45° field of view: 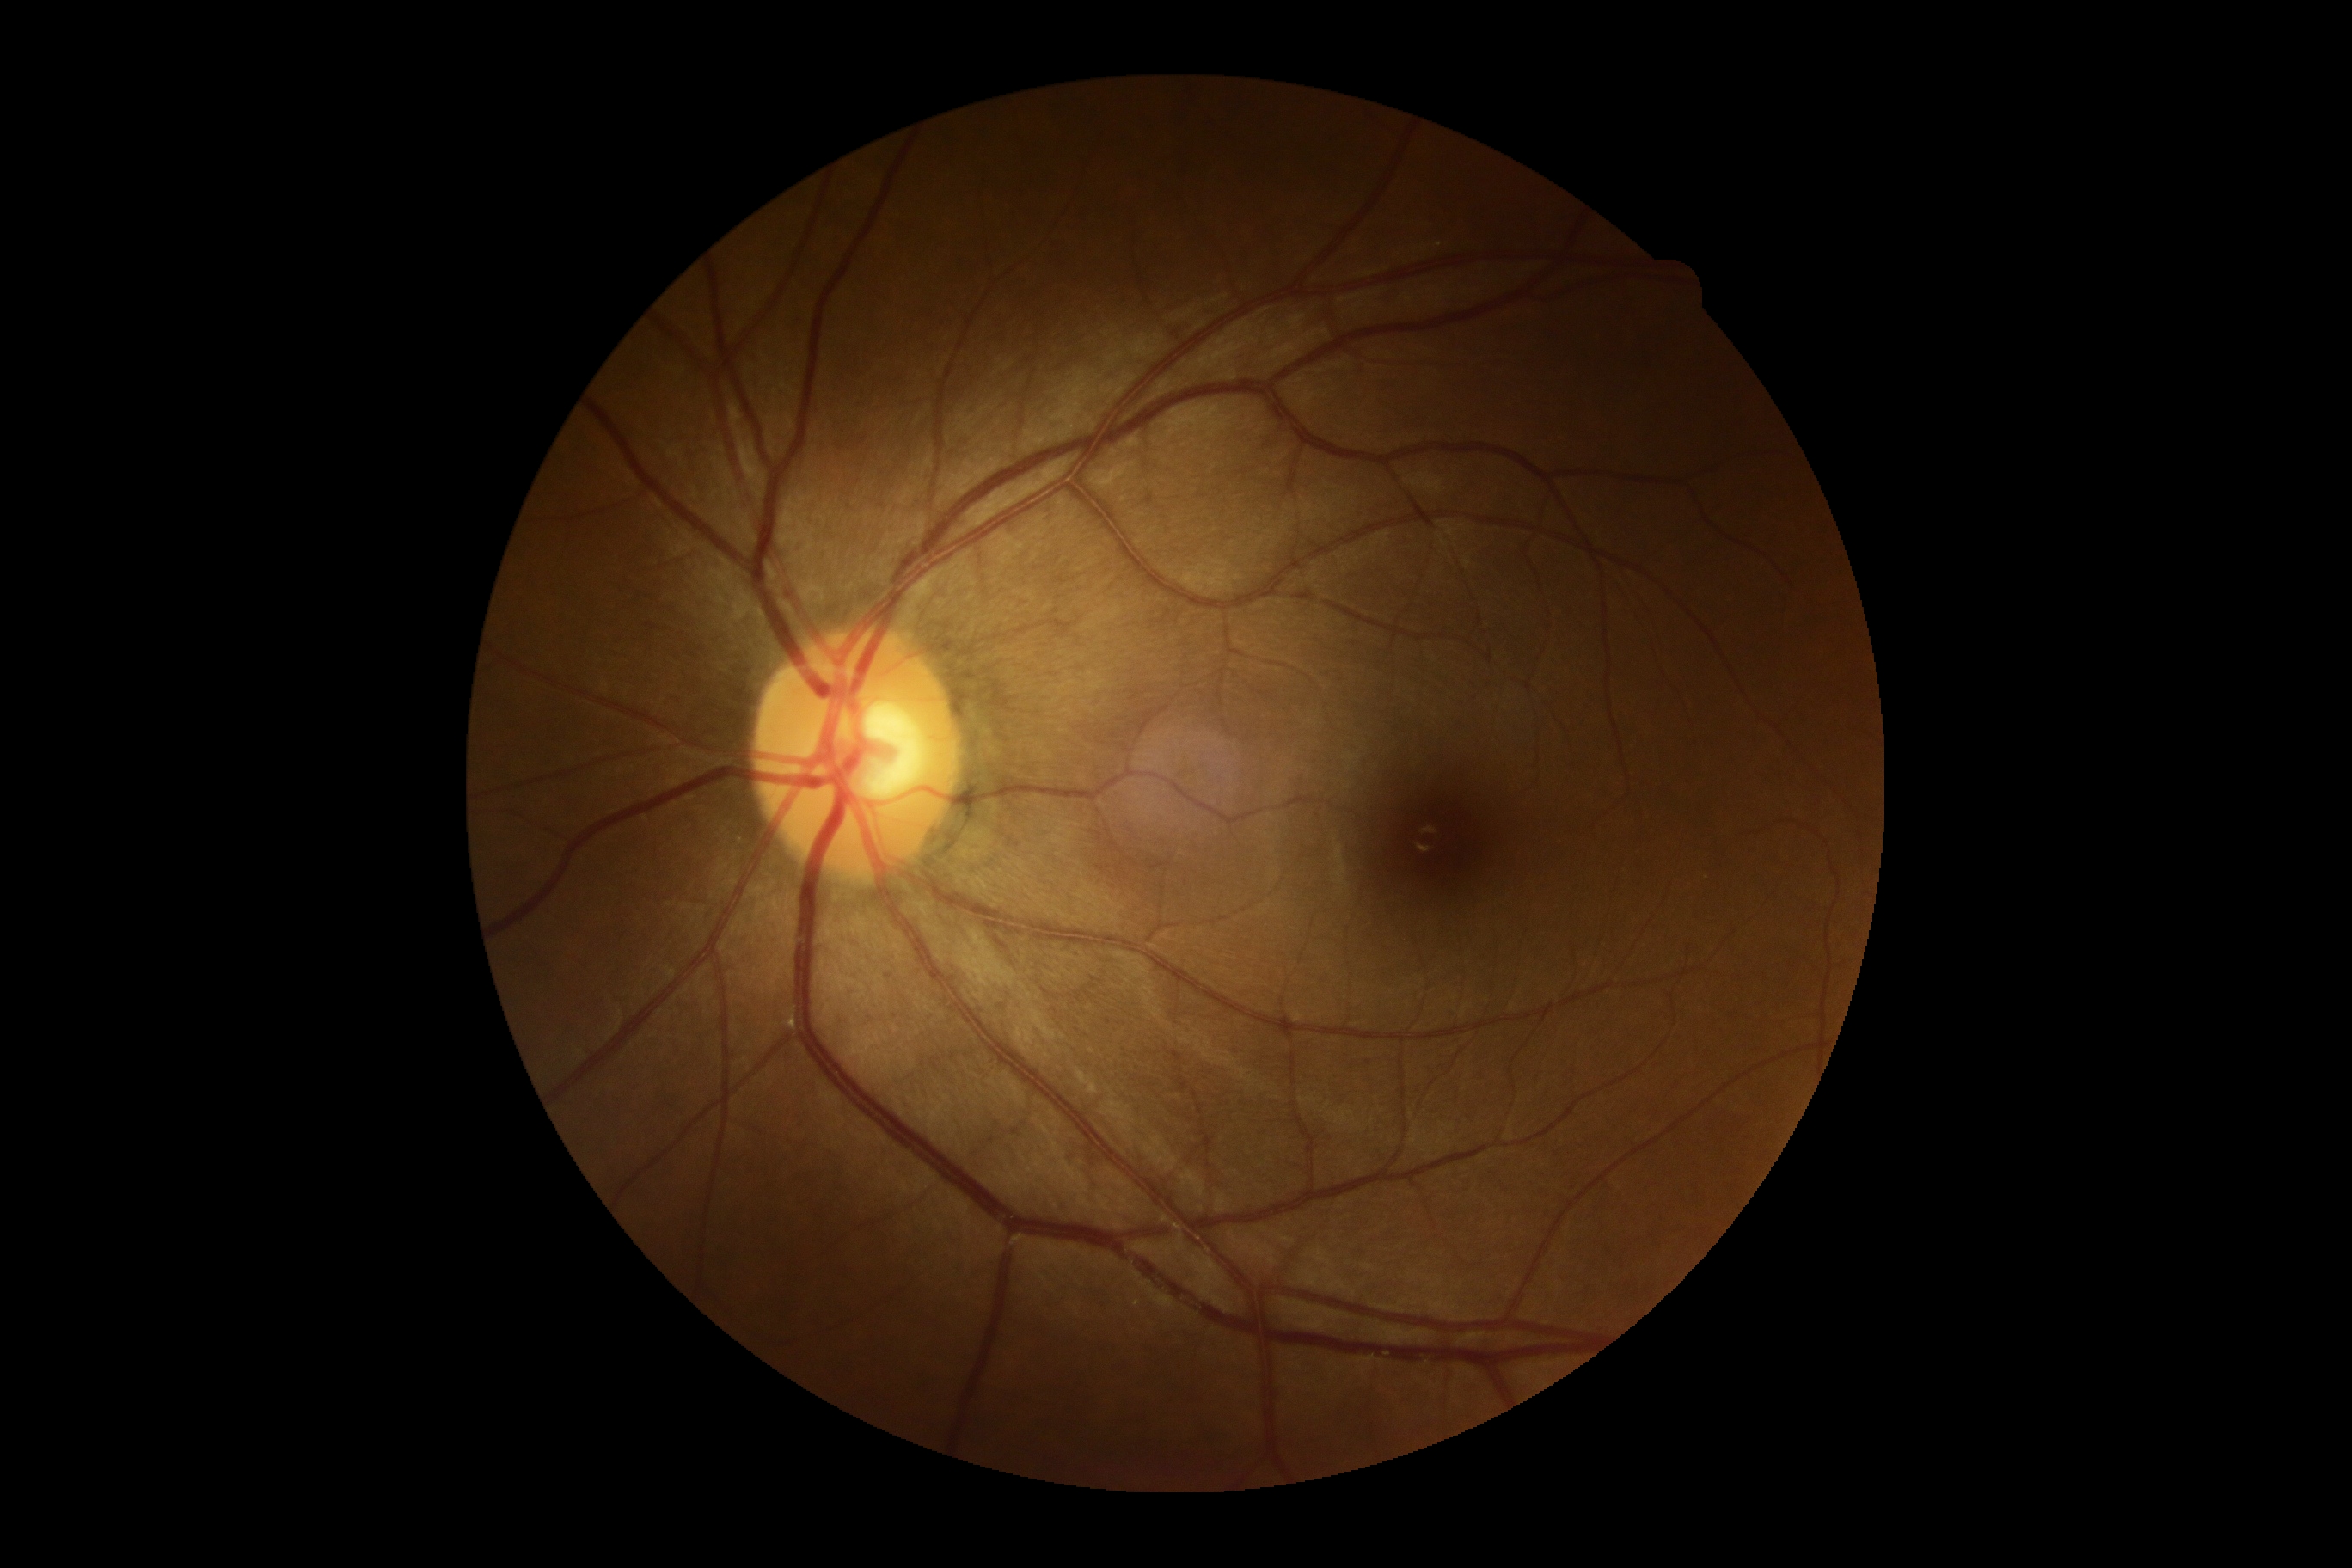 No signs of diabetic retinopathy.
DR severity: no apparent retinopathy (grade 0).